Retinal fundus photograph.
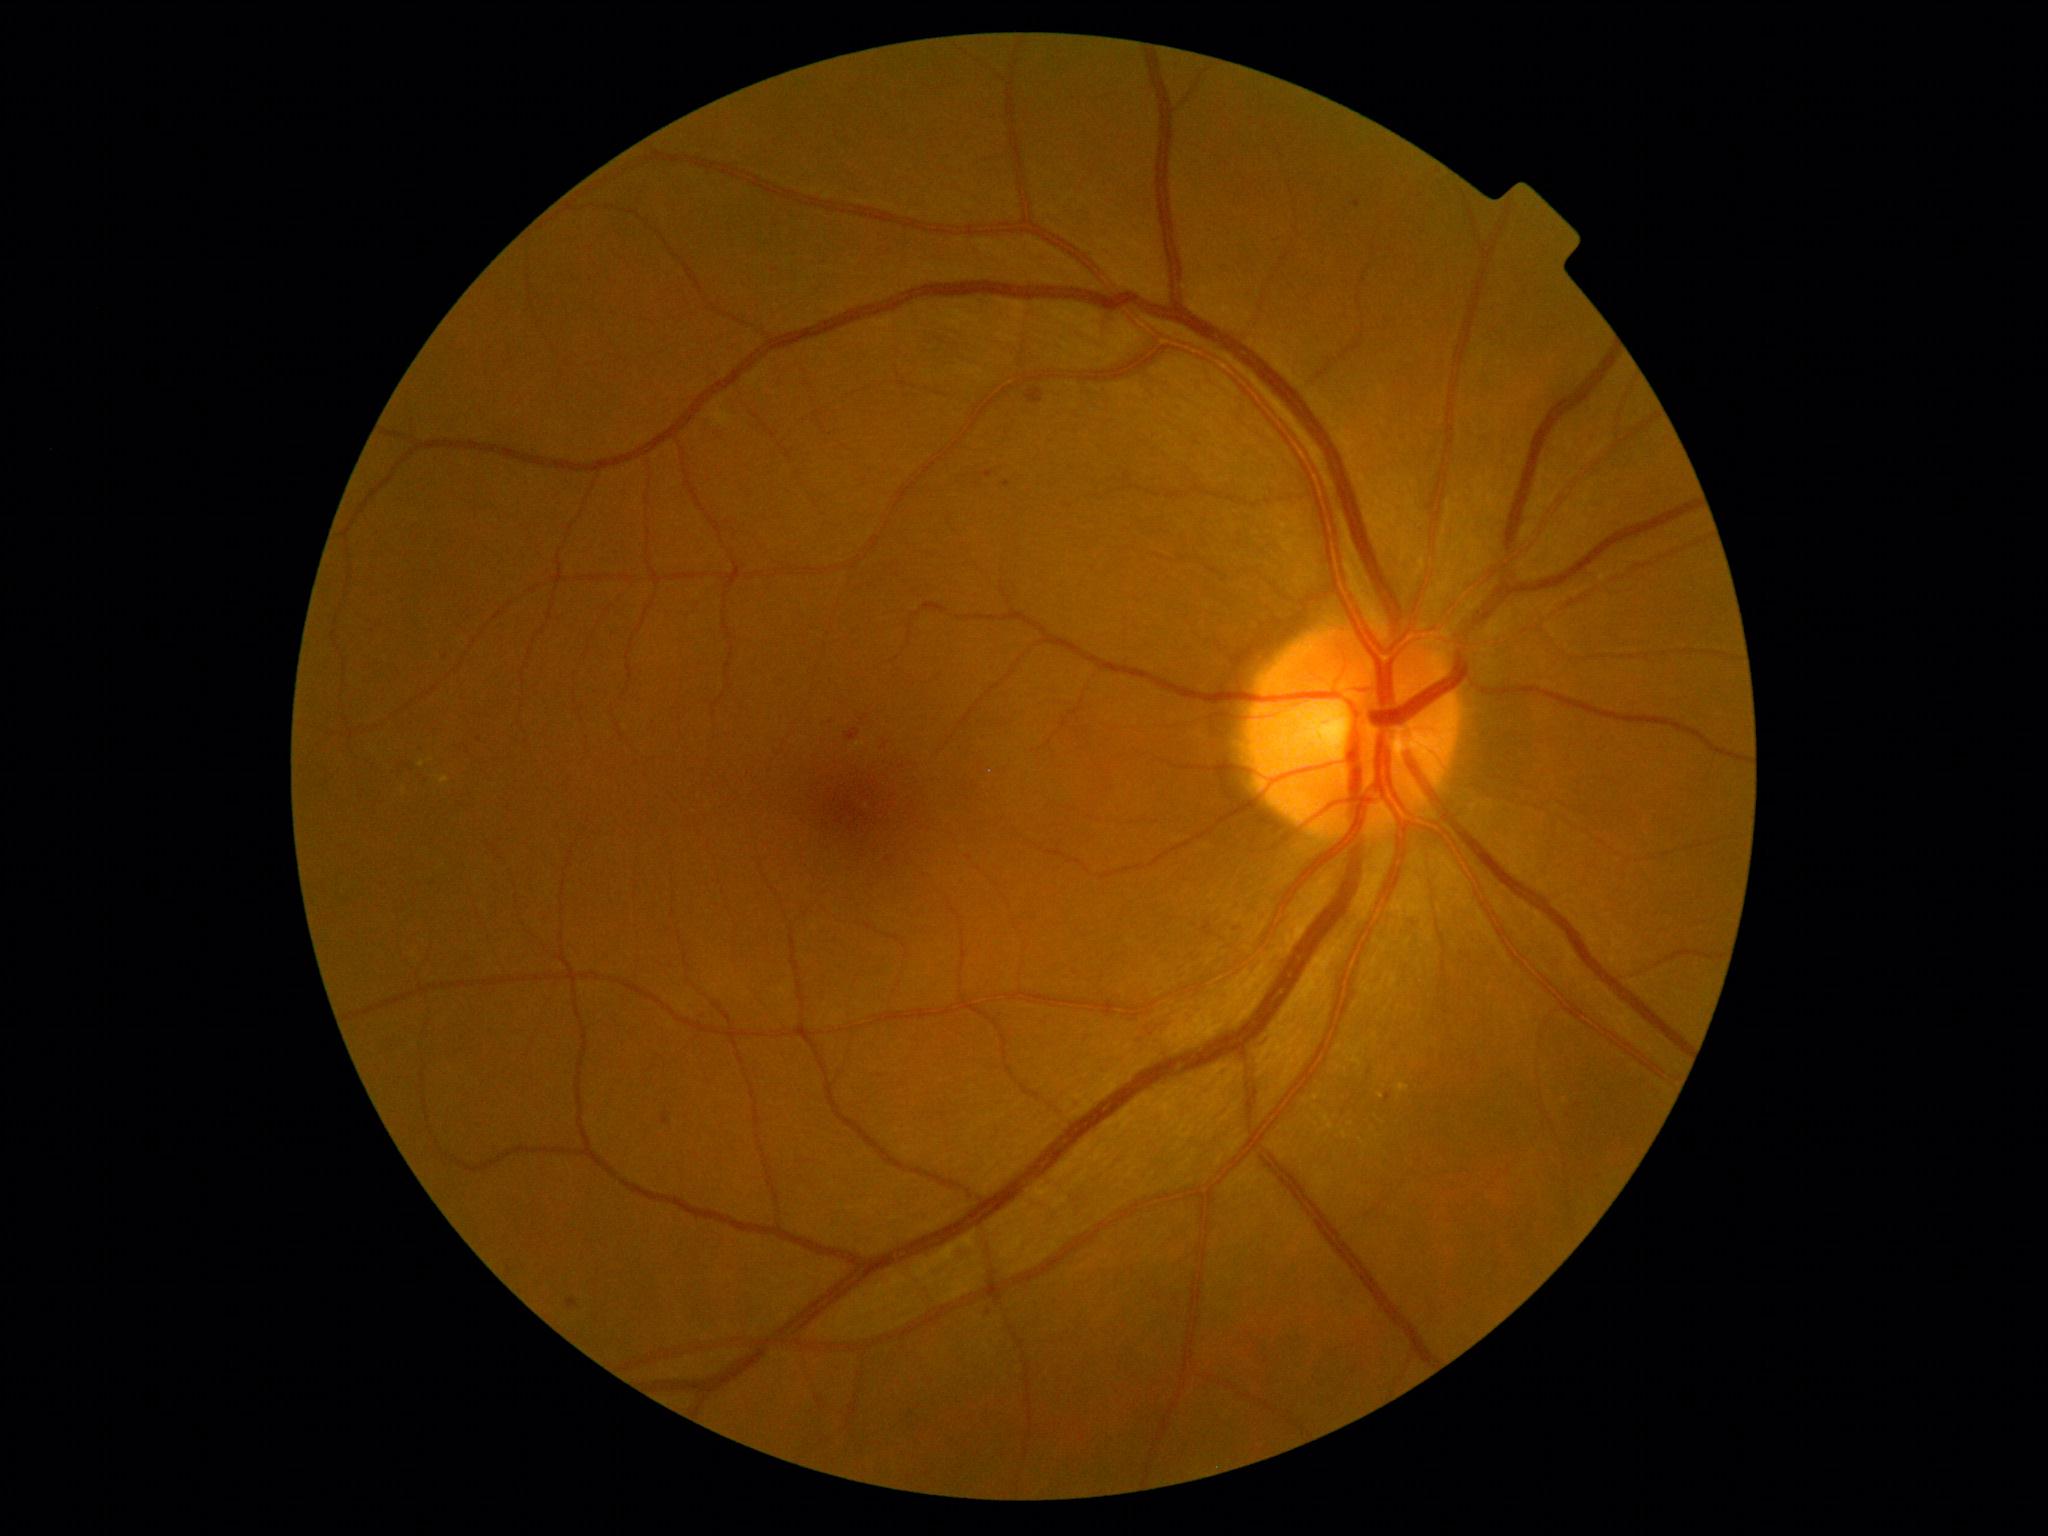

DR is 2/4.